240 x 240 pixels
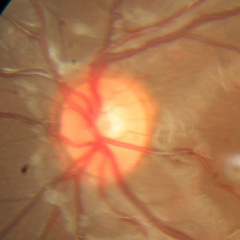 Demonstrates no signs of glaucoma.